Color fundus image · 2048x1536 · 45° FOV.
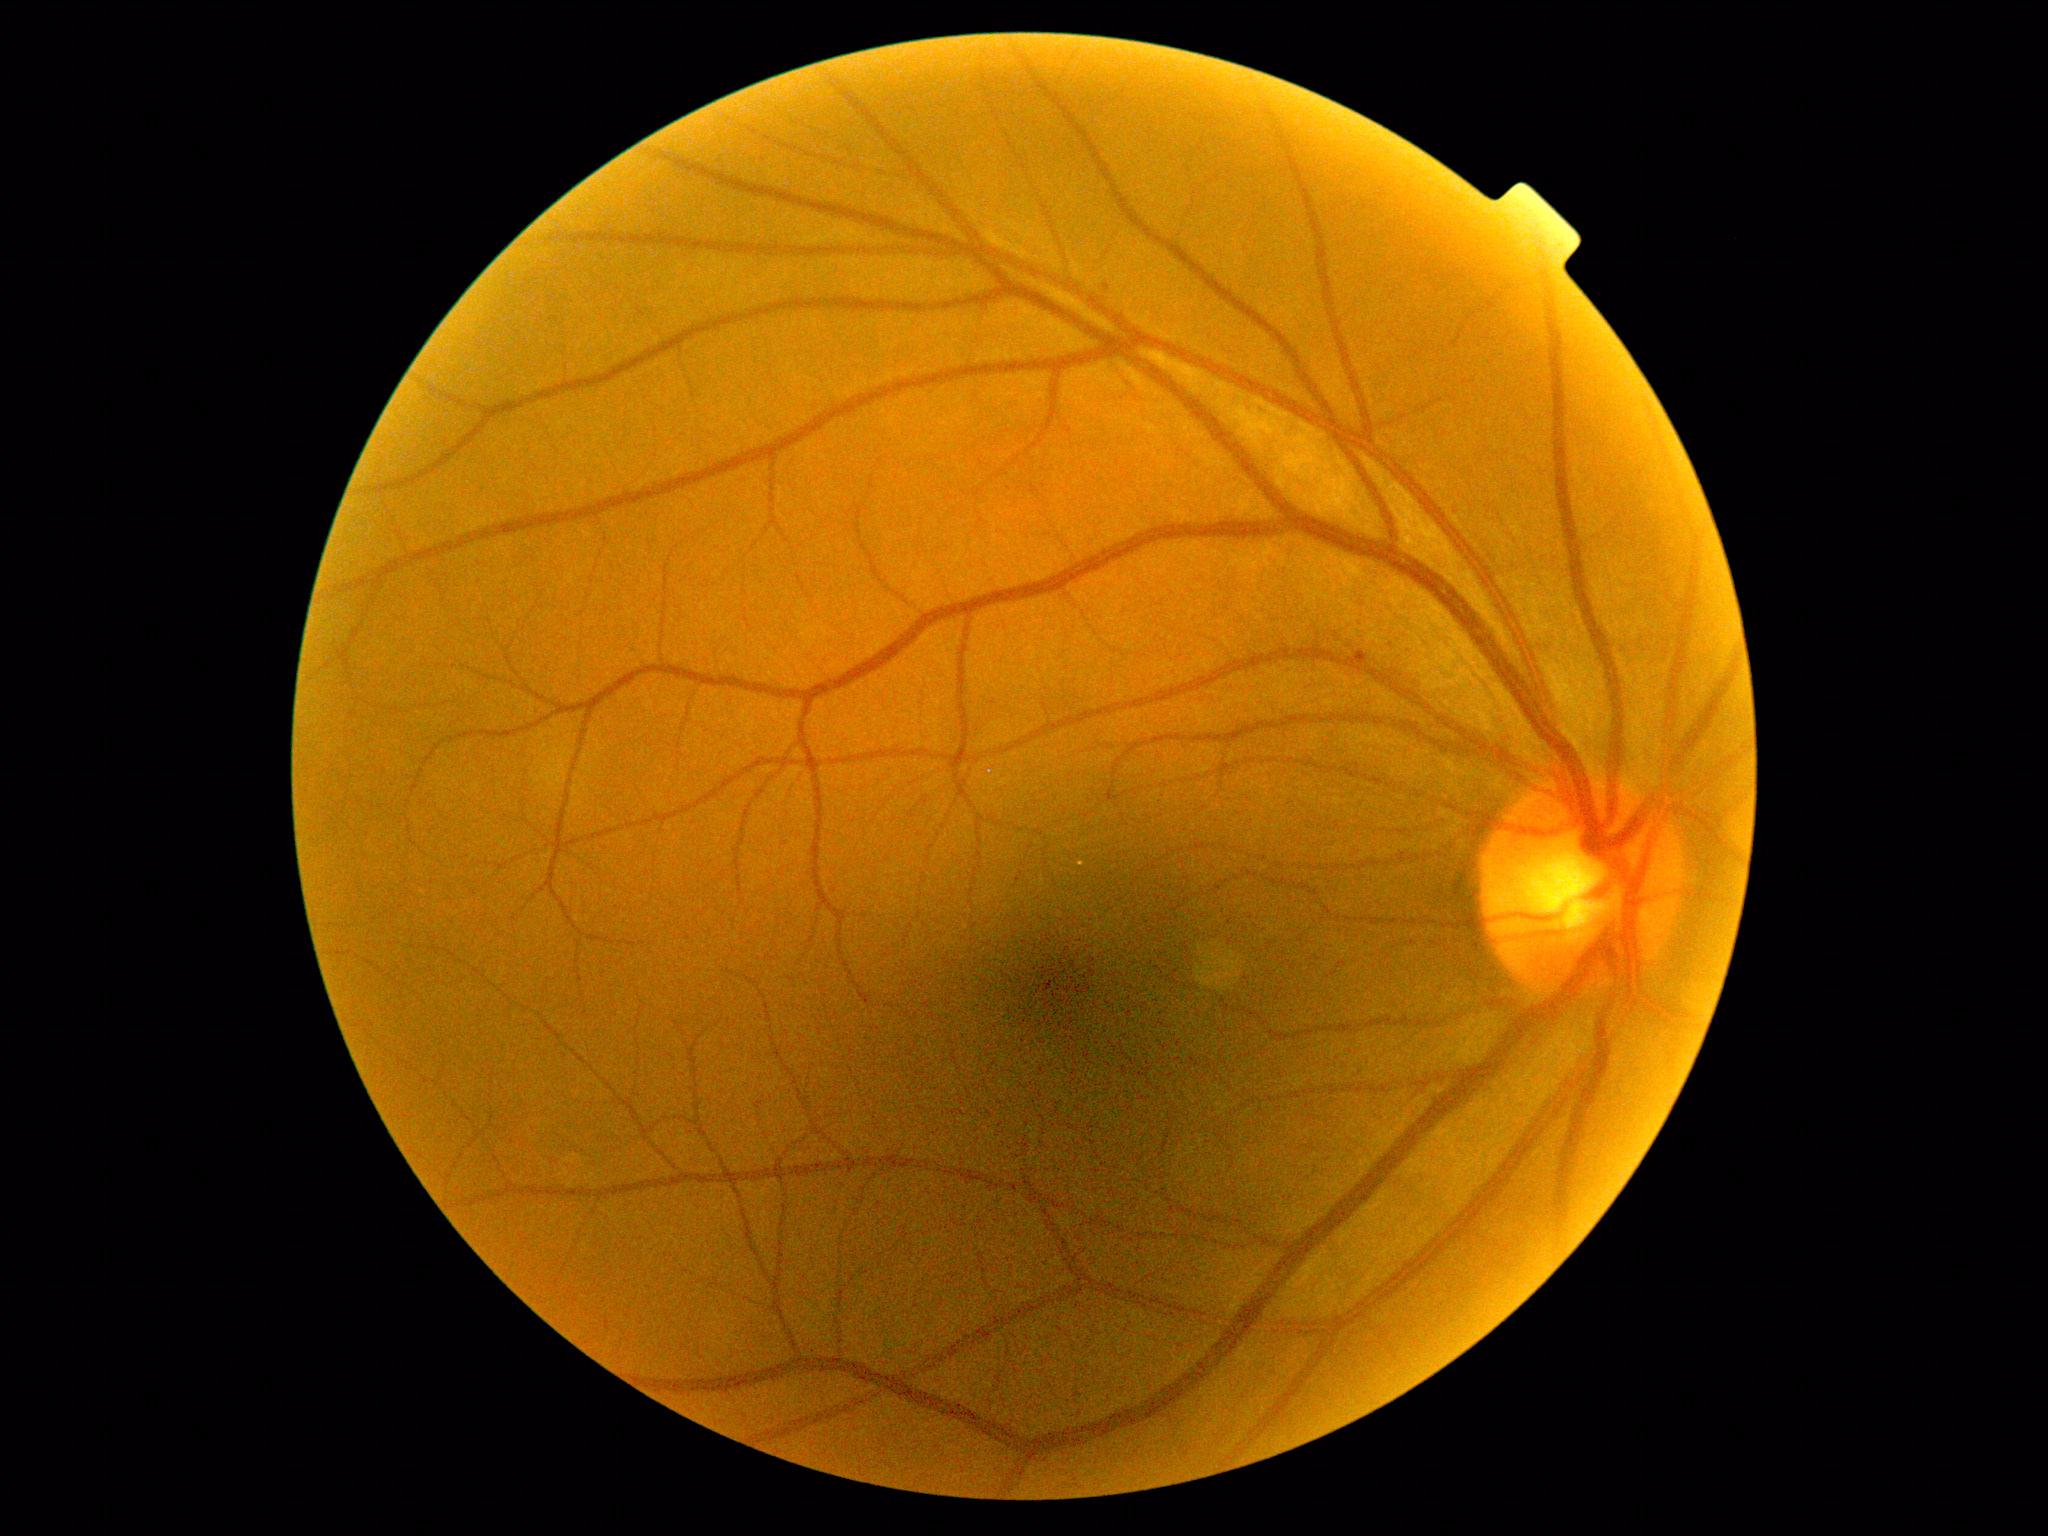
DR grade is 1 — presence of microaneurysms only.